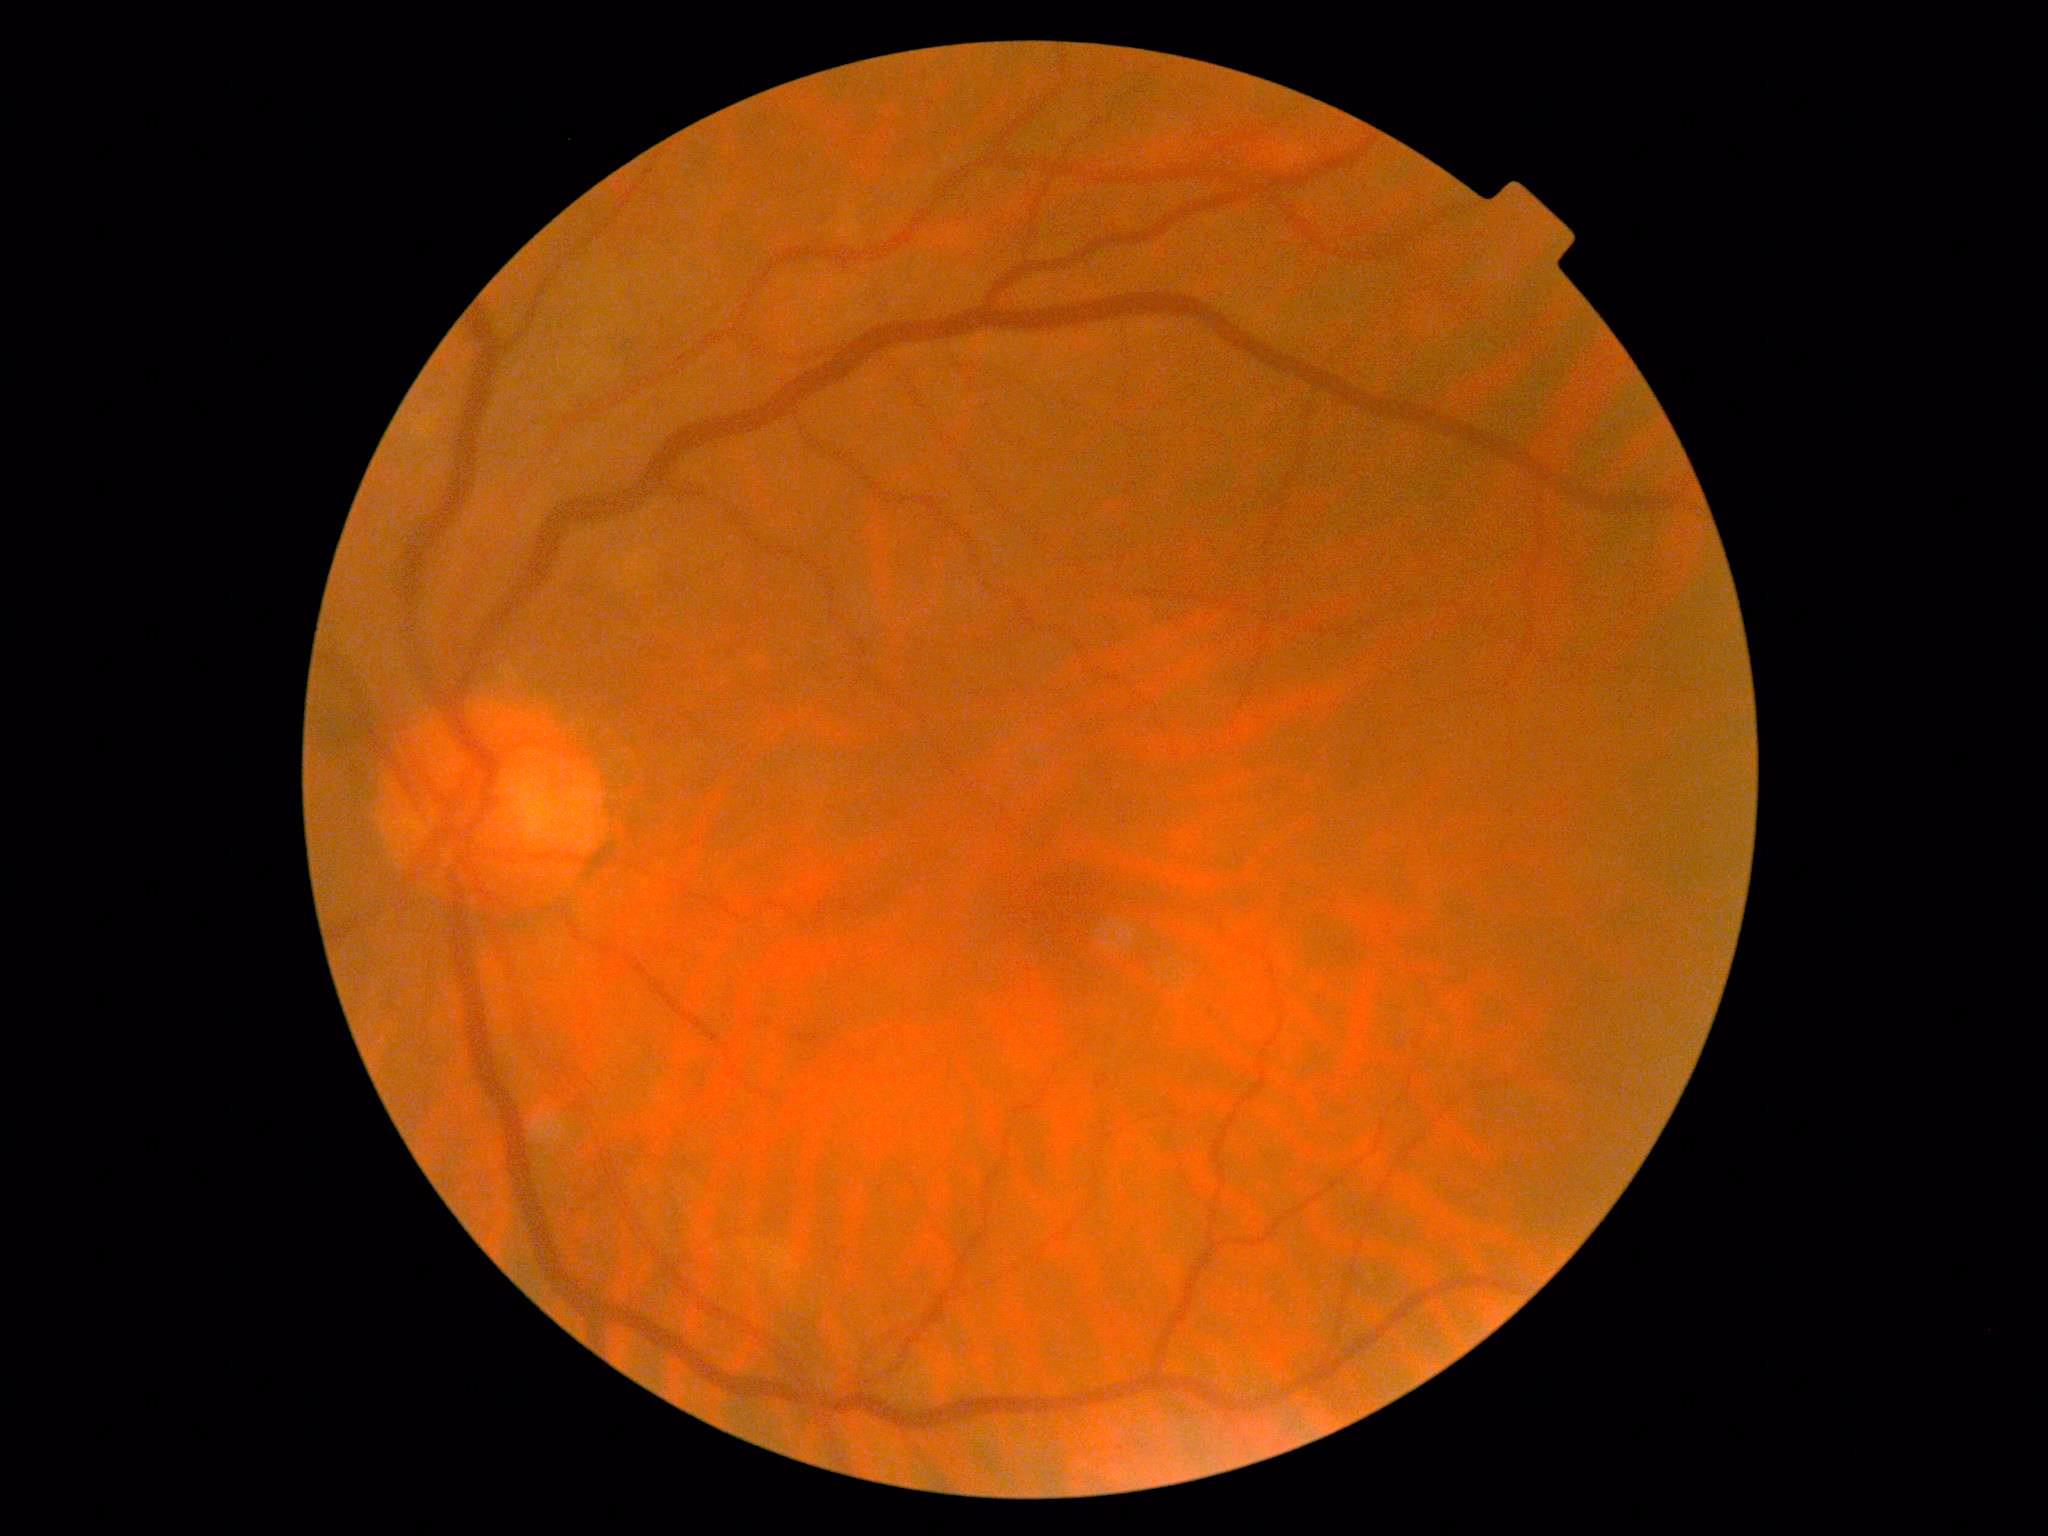 Diabetic retinopathy (DR): no apparent diabetic retinopathy (grade 0).
No DR findings.